848 by 848 pixels, Davis DR grading, CFP, 45-degree field of view, camera: NIDEK AFC-230.
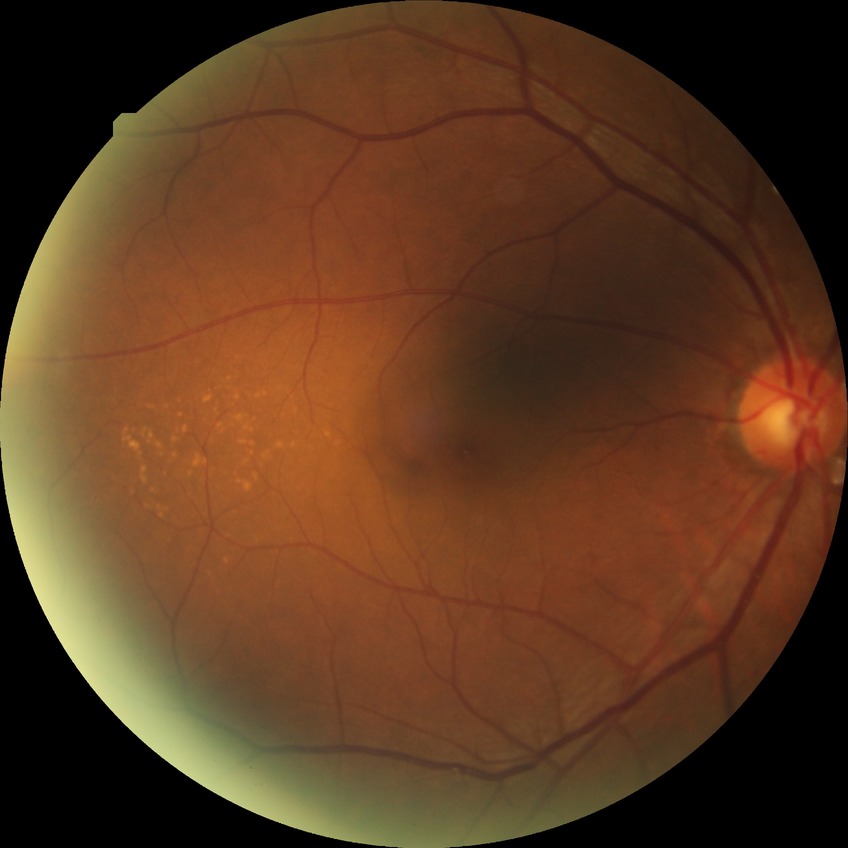

modified Davis grading = simple diabetic retinopathy